Acquired with a NIDEK AFC-230 · color fundus image · 848x848px — 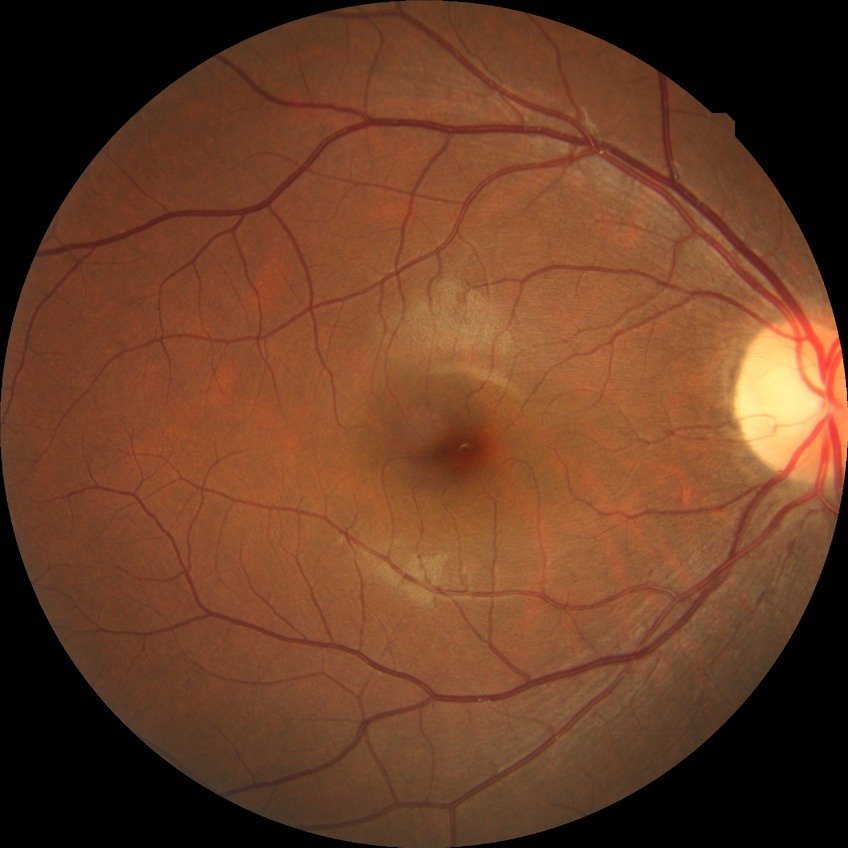
Davis DR grade: NDR.